Fundus photo — 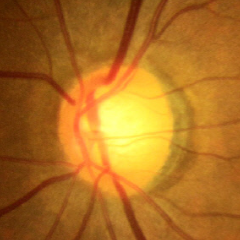 Q: Is glaucoma present?
A: Early-stage glaucoma.